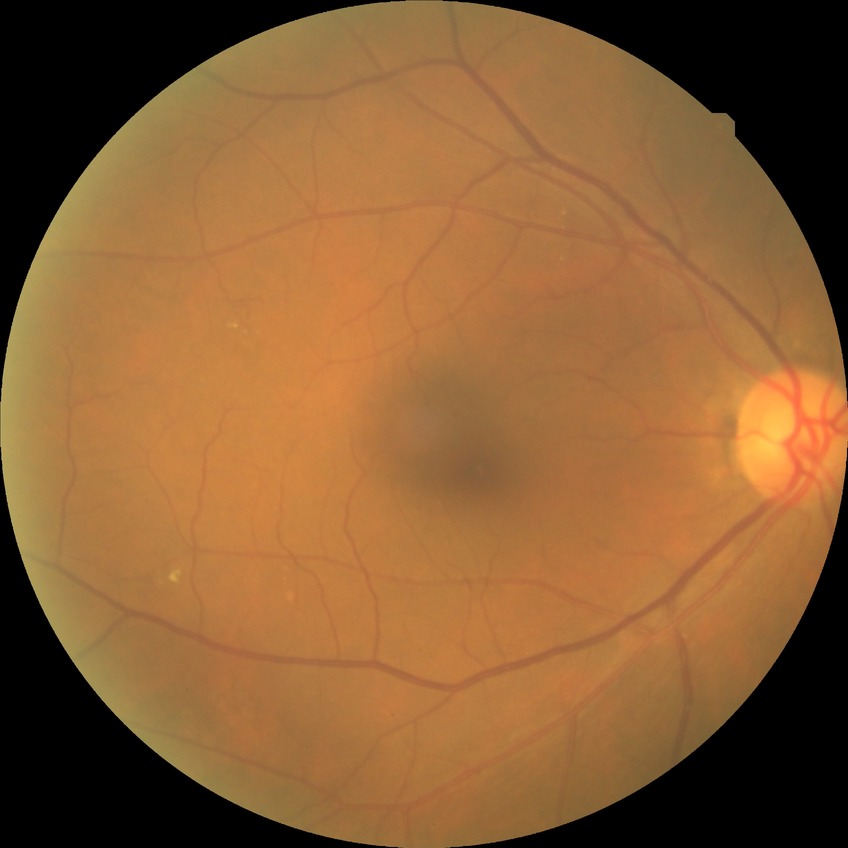

Diabetic retinopathy (DR) is NDR (no diabetic retinopathy).